Acquired with a Nidek AFC-330: 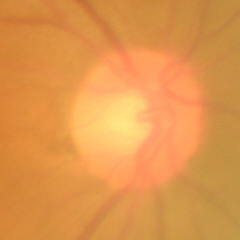 This fundus photograph shows no glaucomatous changes.